CFP; captured on a Remidio smartphone fundus camera; 1659x2212px: 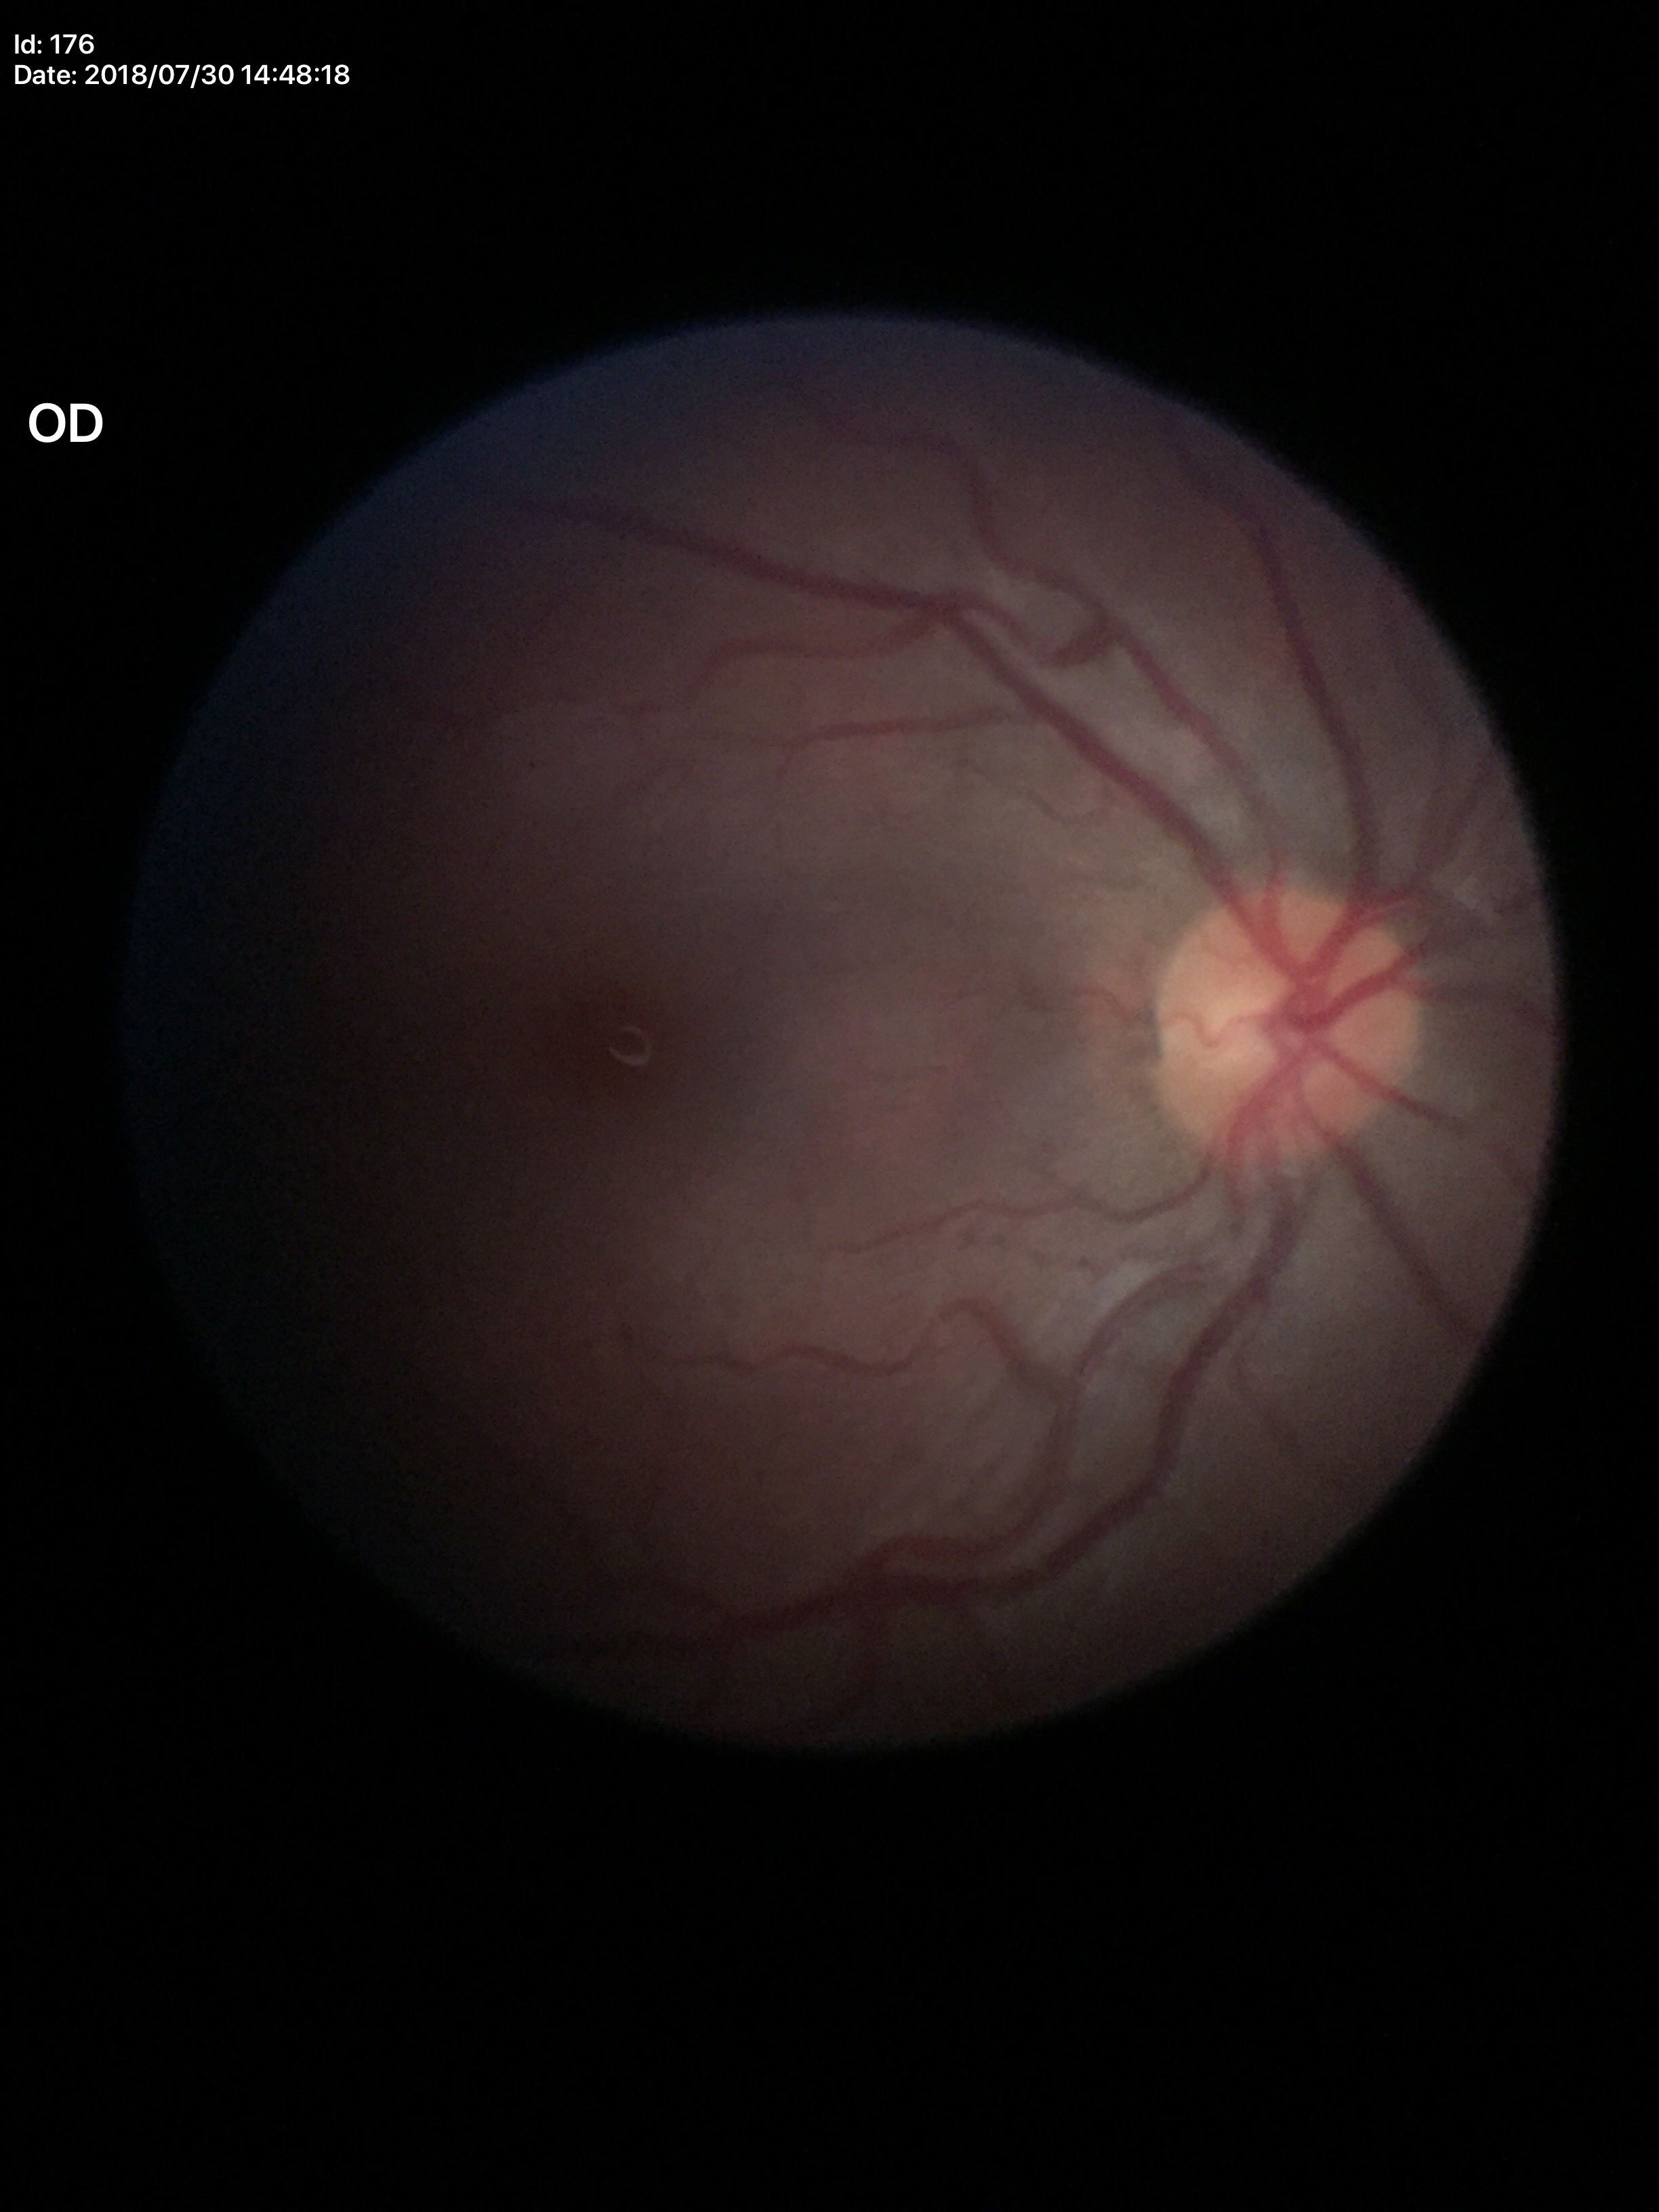 Glaucoma evaluation: not suspect. Vertical cup-to-disc ratio: 0.54.